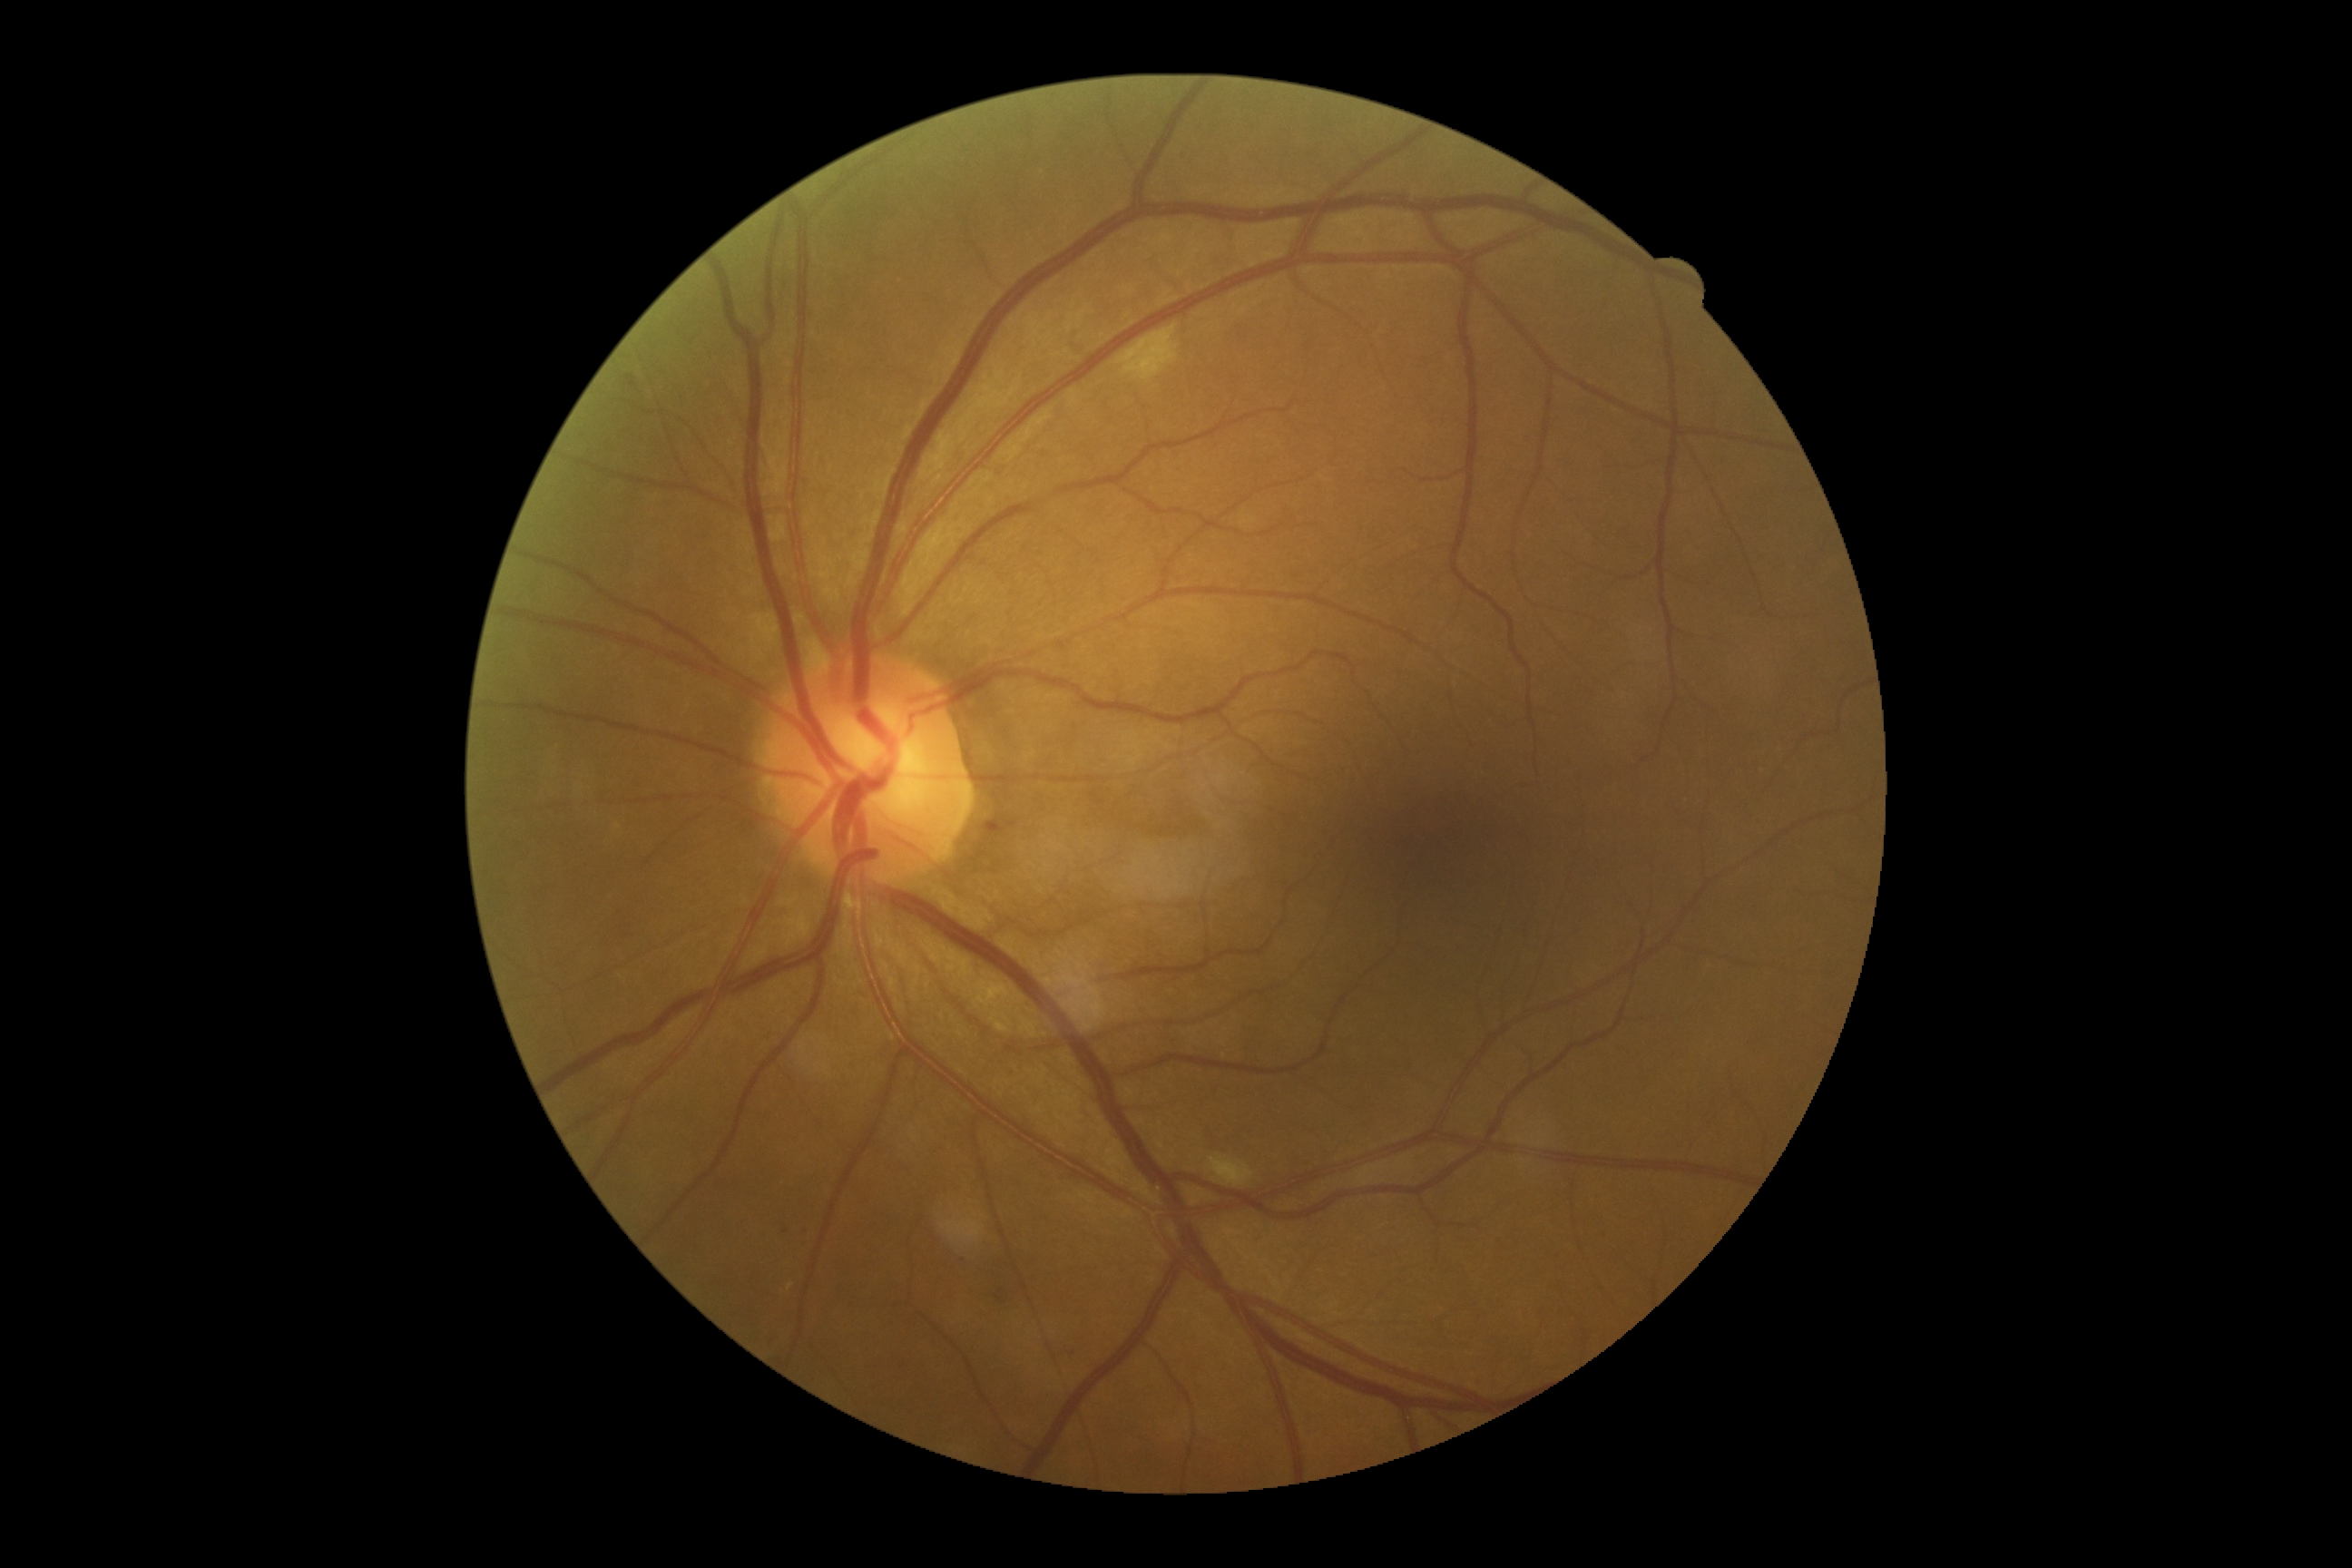
  dr_category: non-proliferative diabetic retinopathy
  dr_grade: 2/4